Centered on the macula.
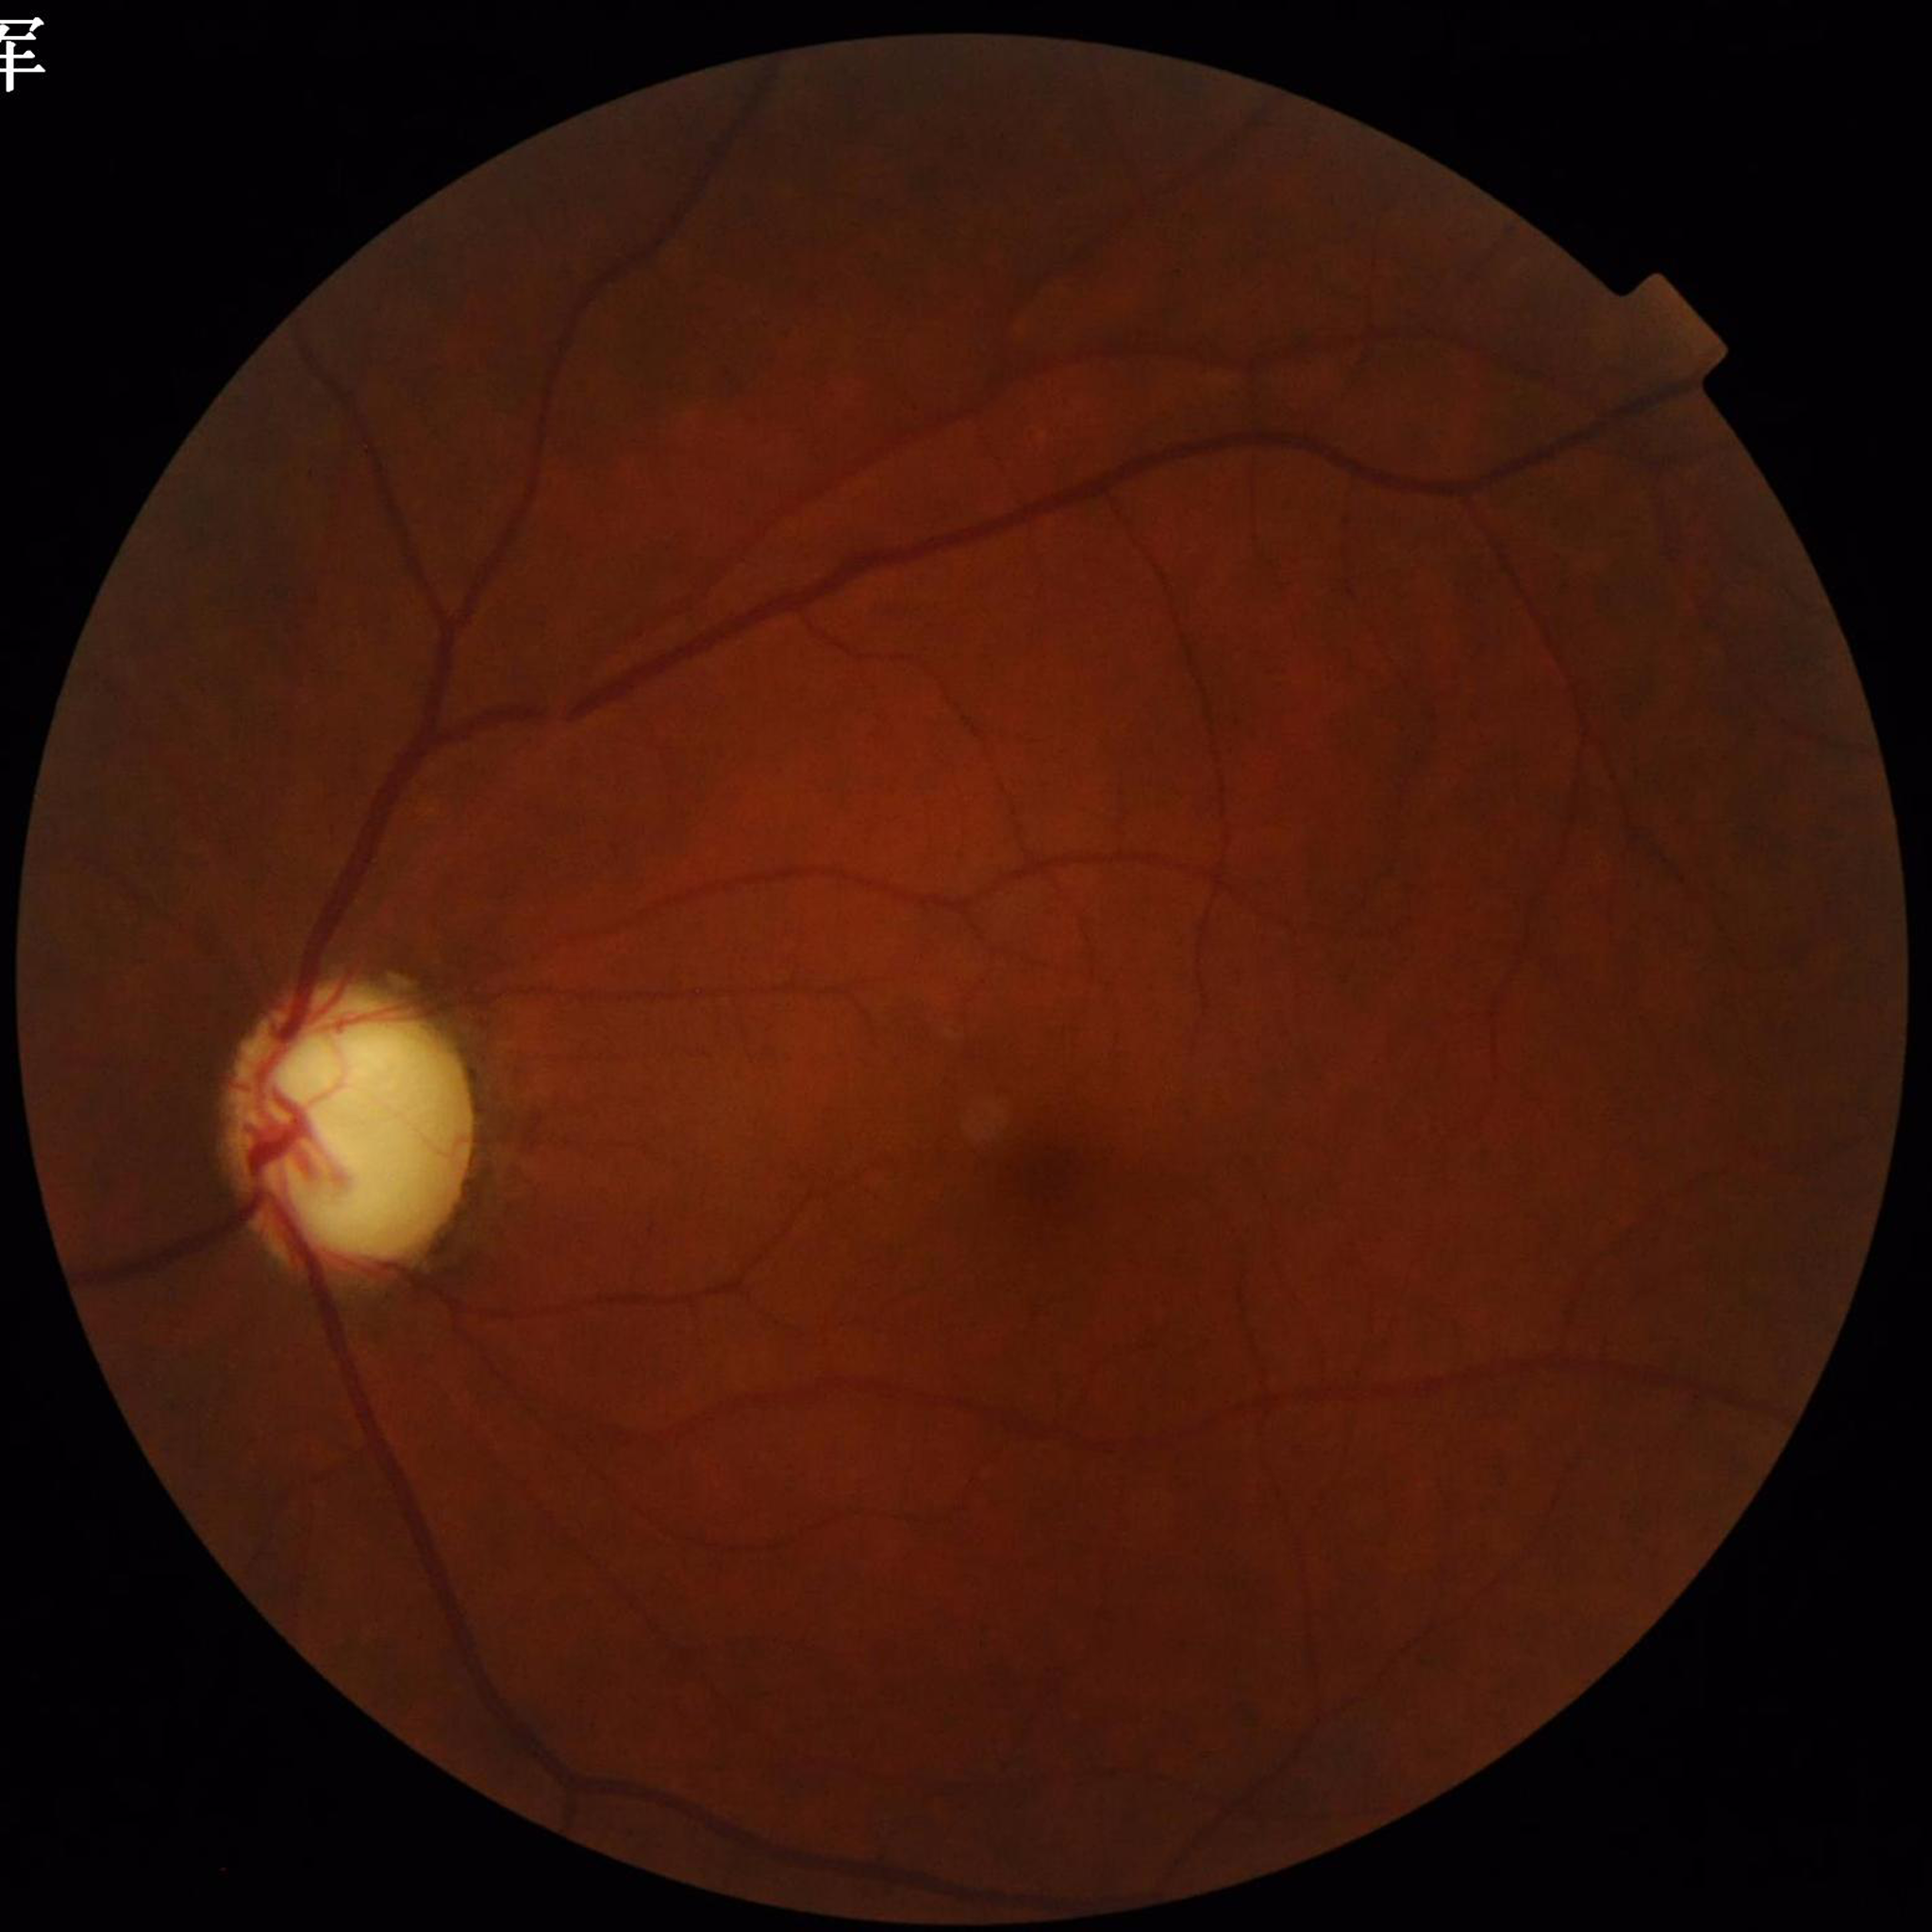

Disease = glaucoma